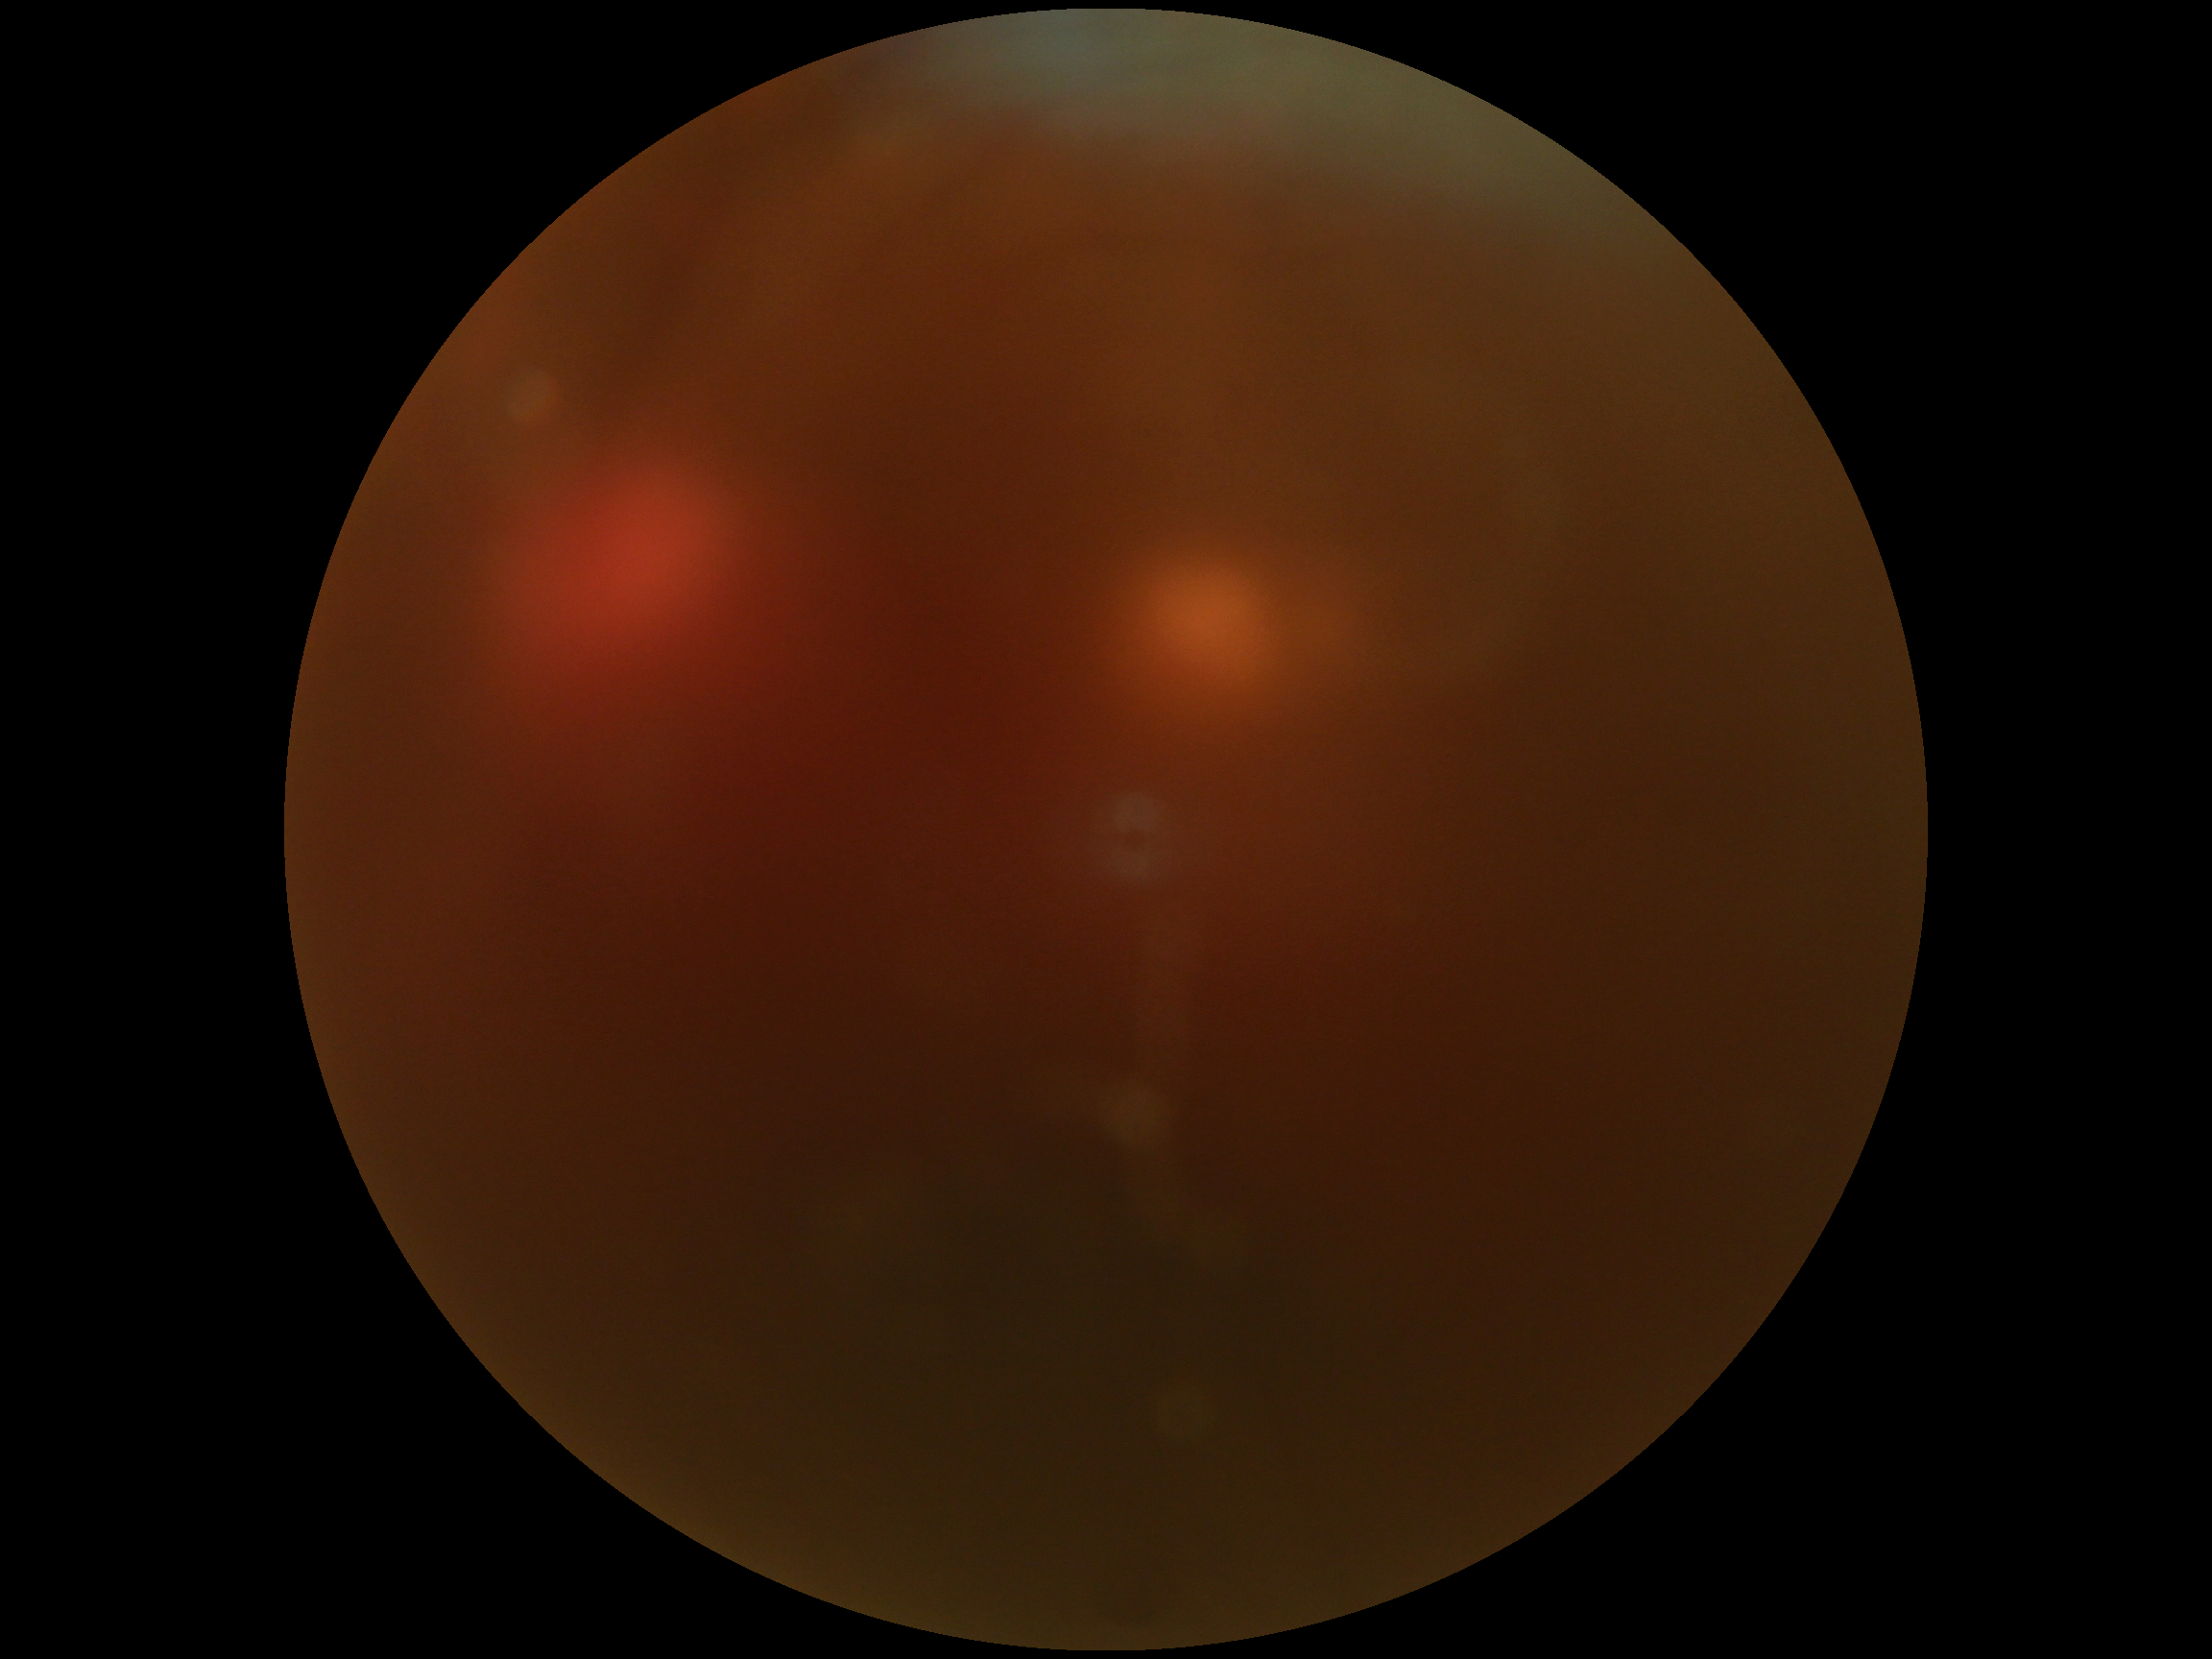

diabetic retinopathy (DR)=ungradable.